FOV: 45 degrees: 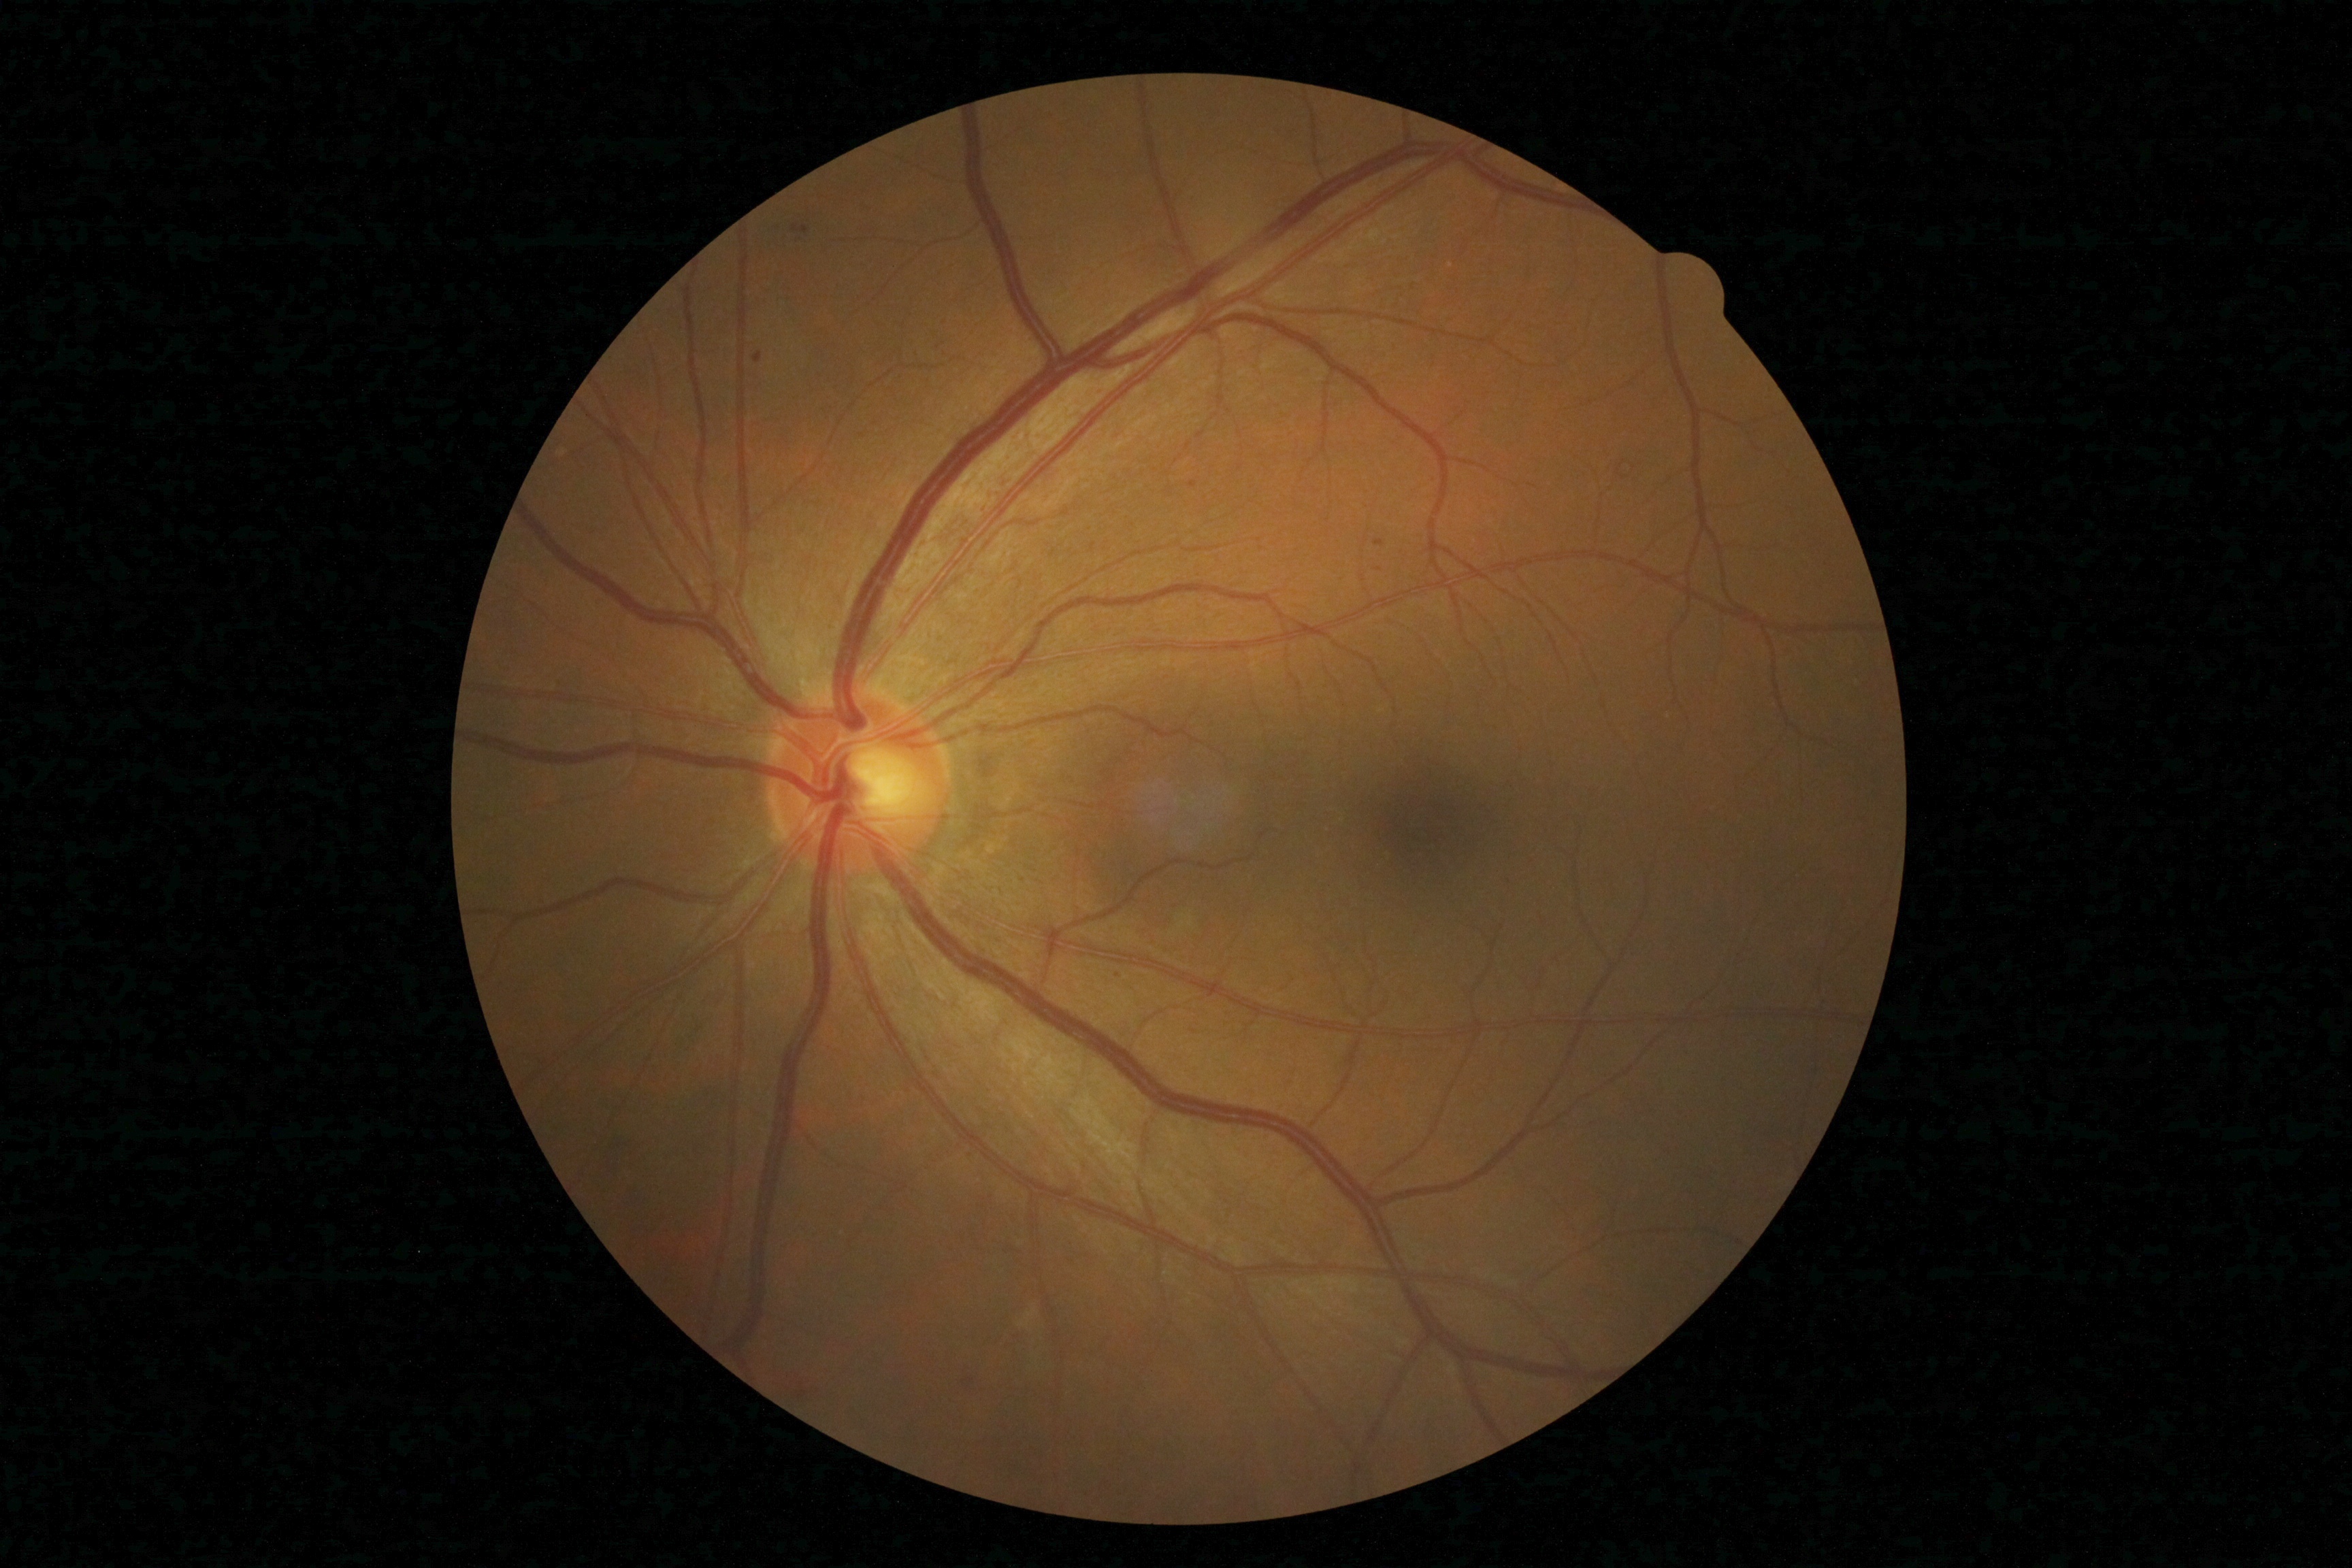

DR class: non-proliferative diabetic retinopathy. Diabetic retinopathy is grade 2 (moderate NPDR) — more than just microaneurysms but less than severe NPDR.